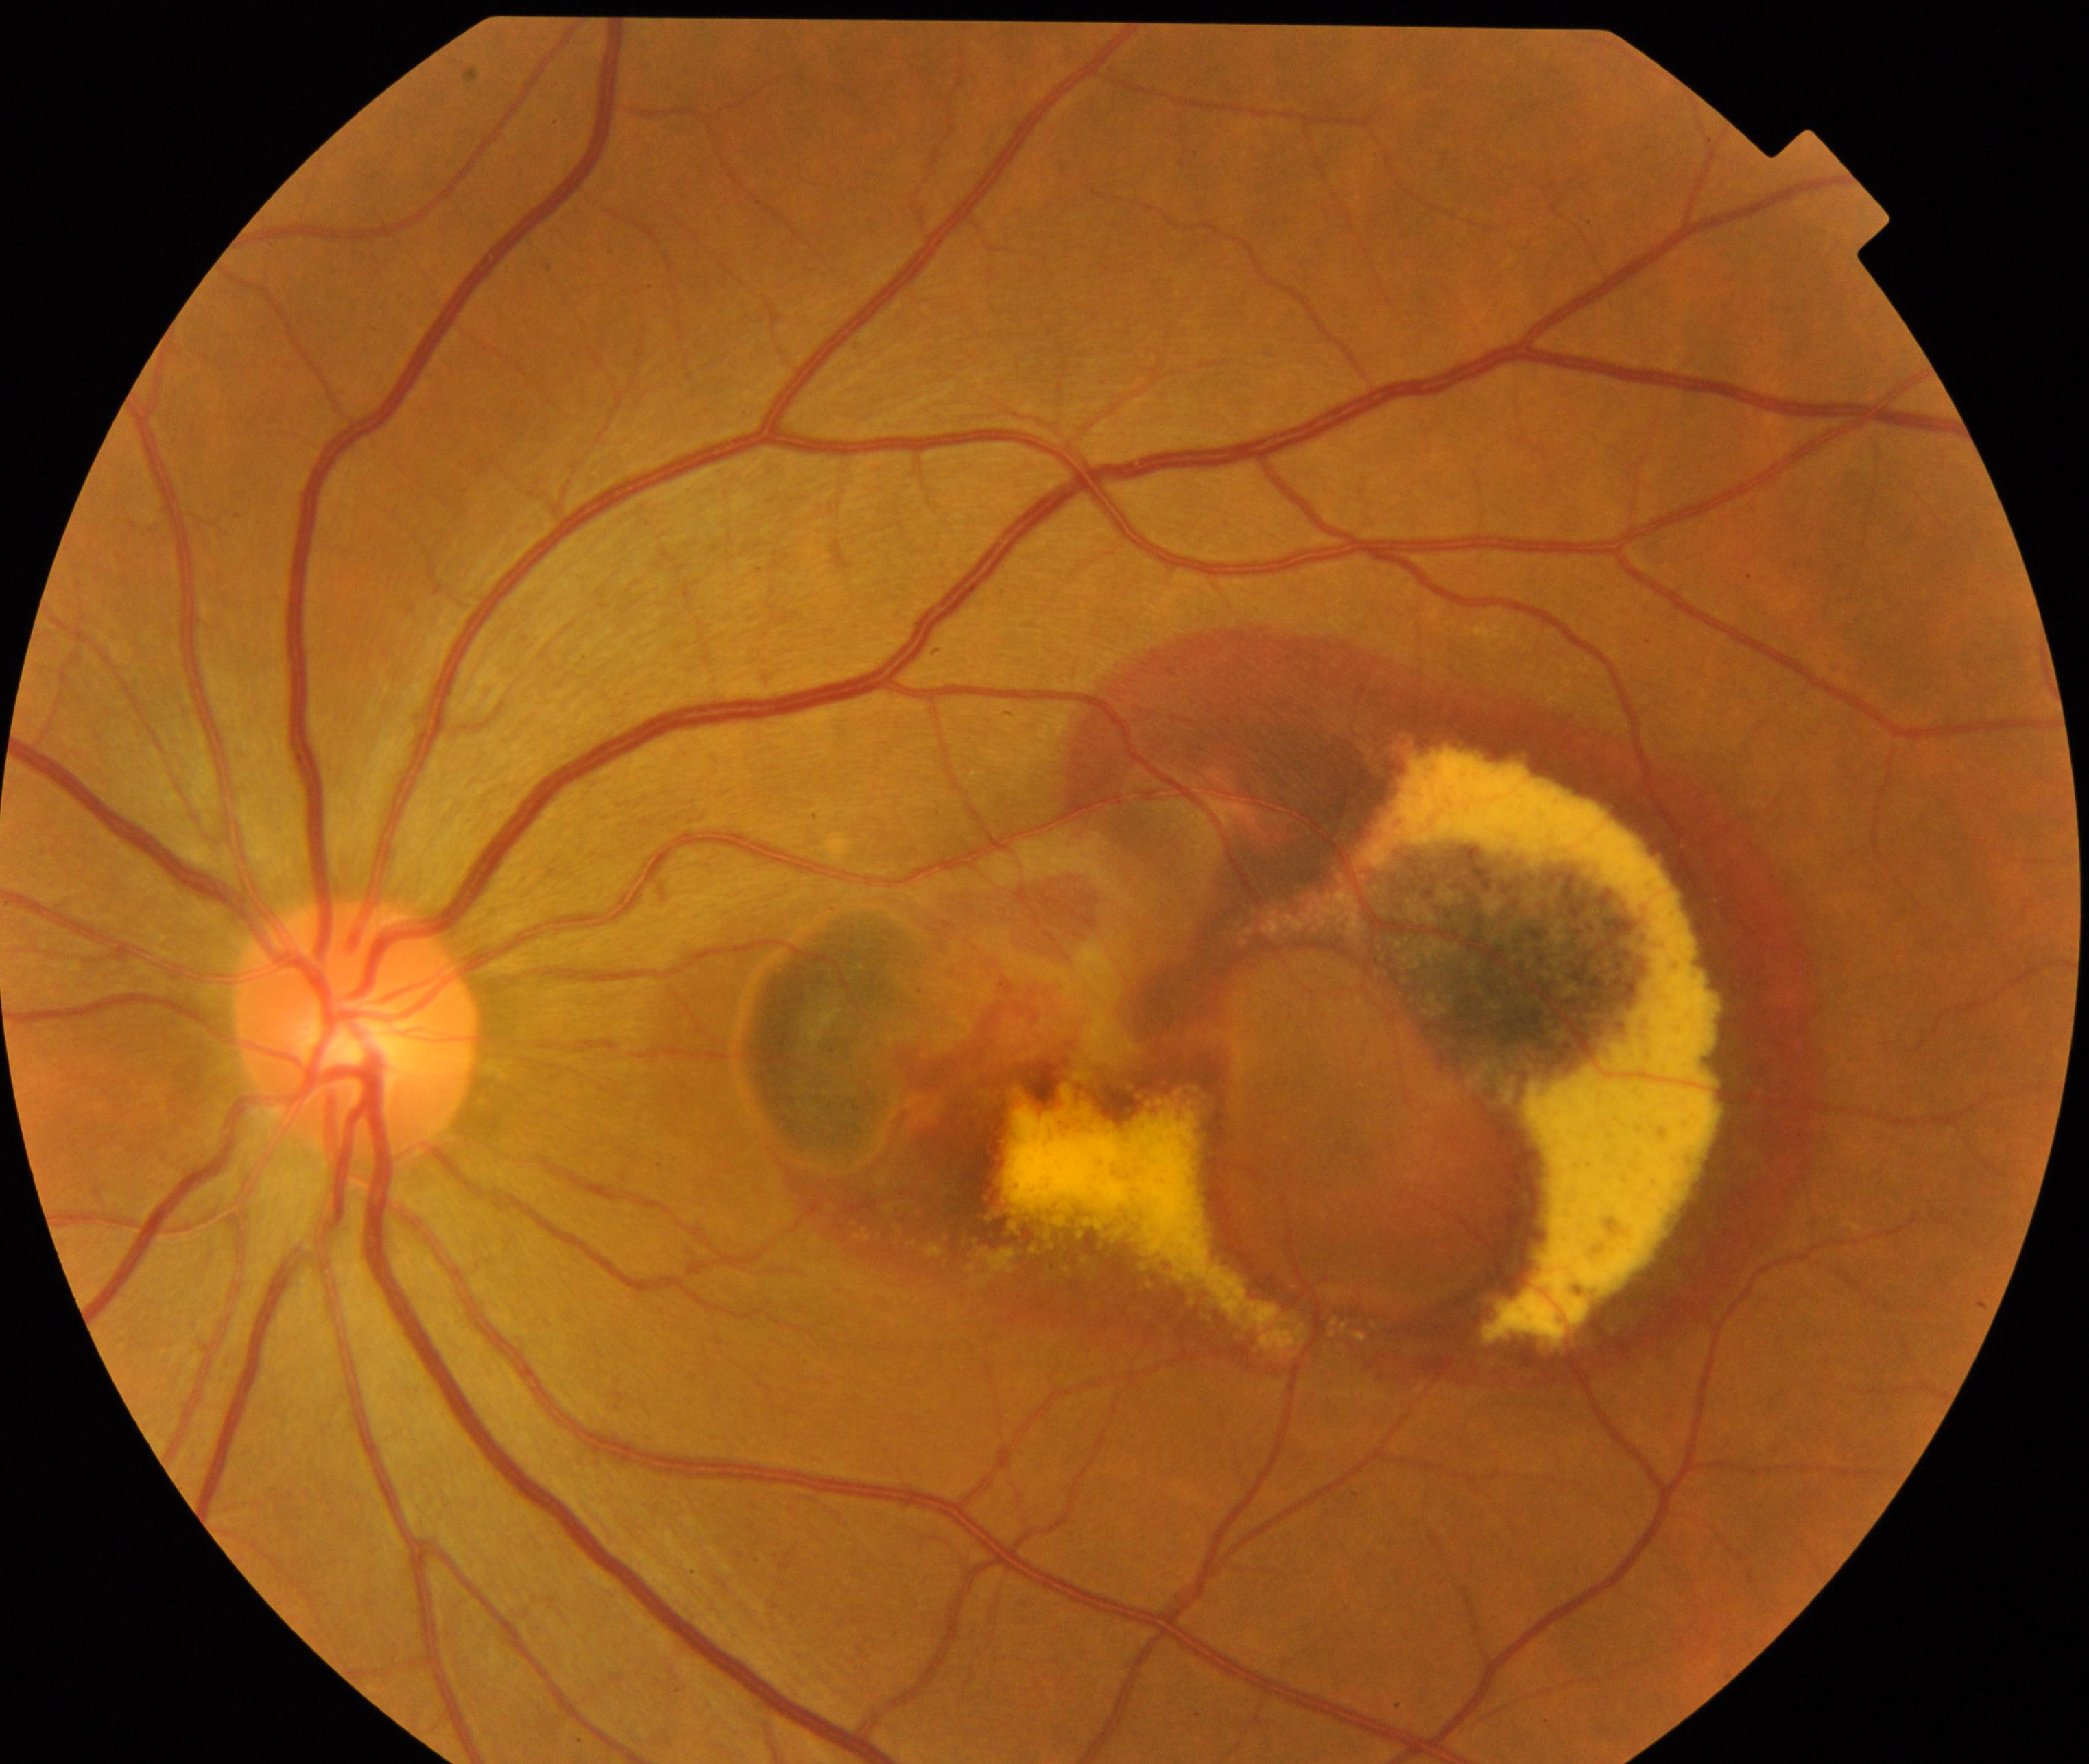 Impression: maculopathy.